848x848px, fundus photo, NIDEK AFC-230 — 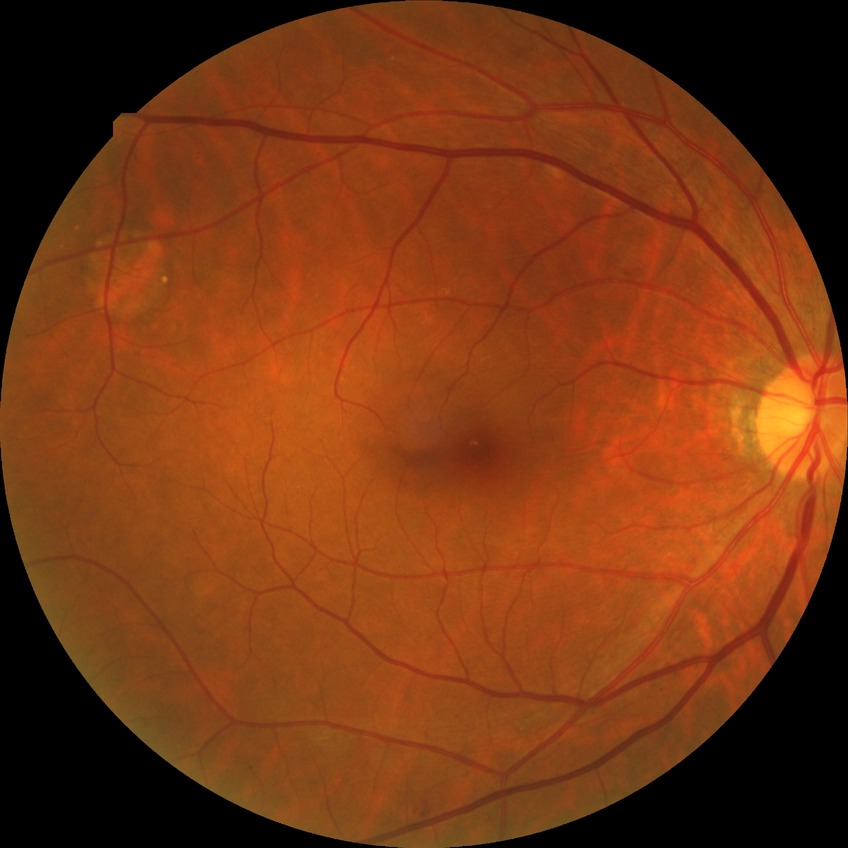
DR class: non-proliferative diabetic retinopathy, diabetic retinopathy (DR): SDR (simple diabetic retinopathy).